Fundus photo
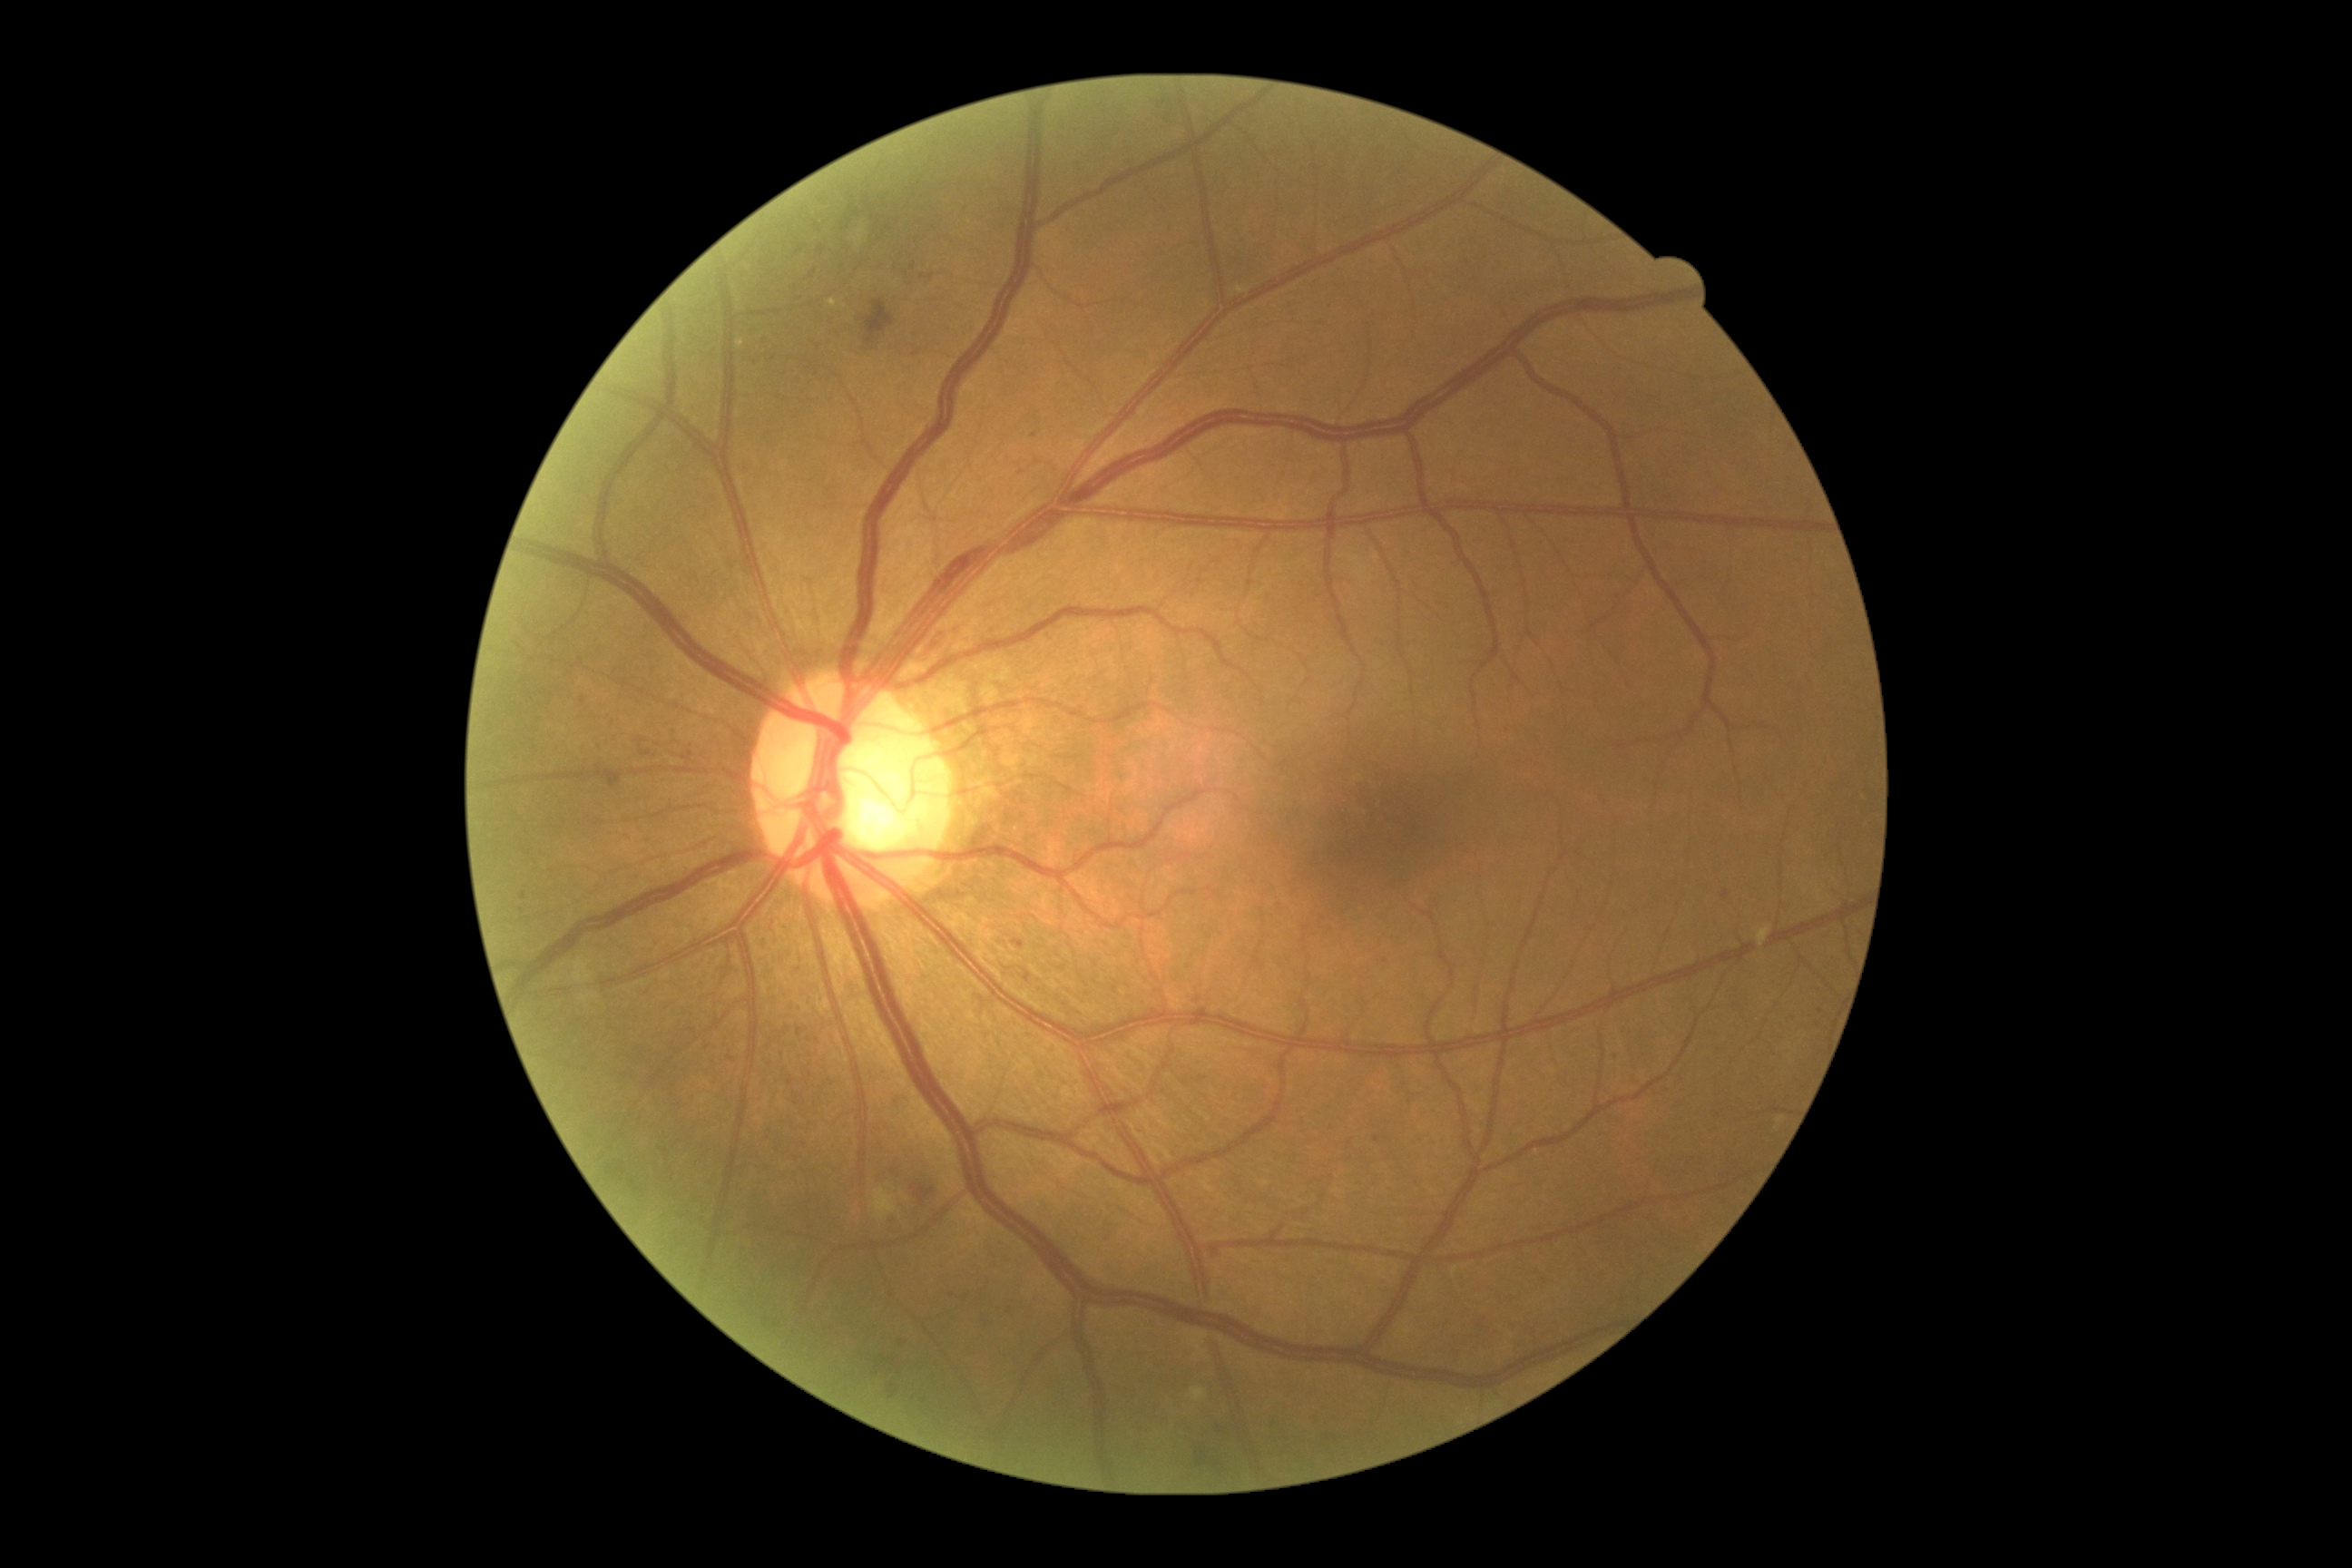
{
  "dr_grade": "2"
}